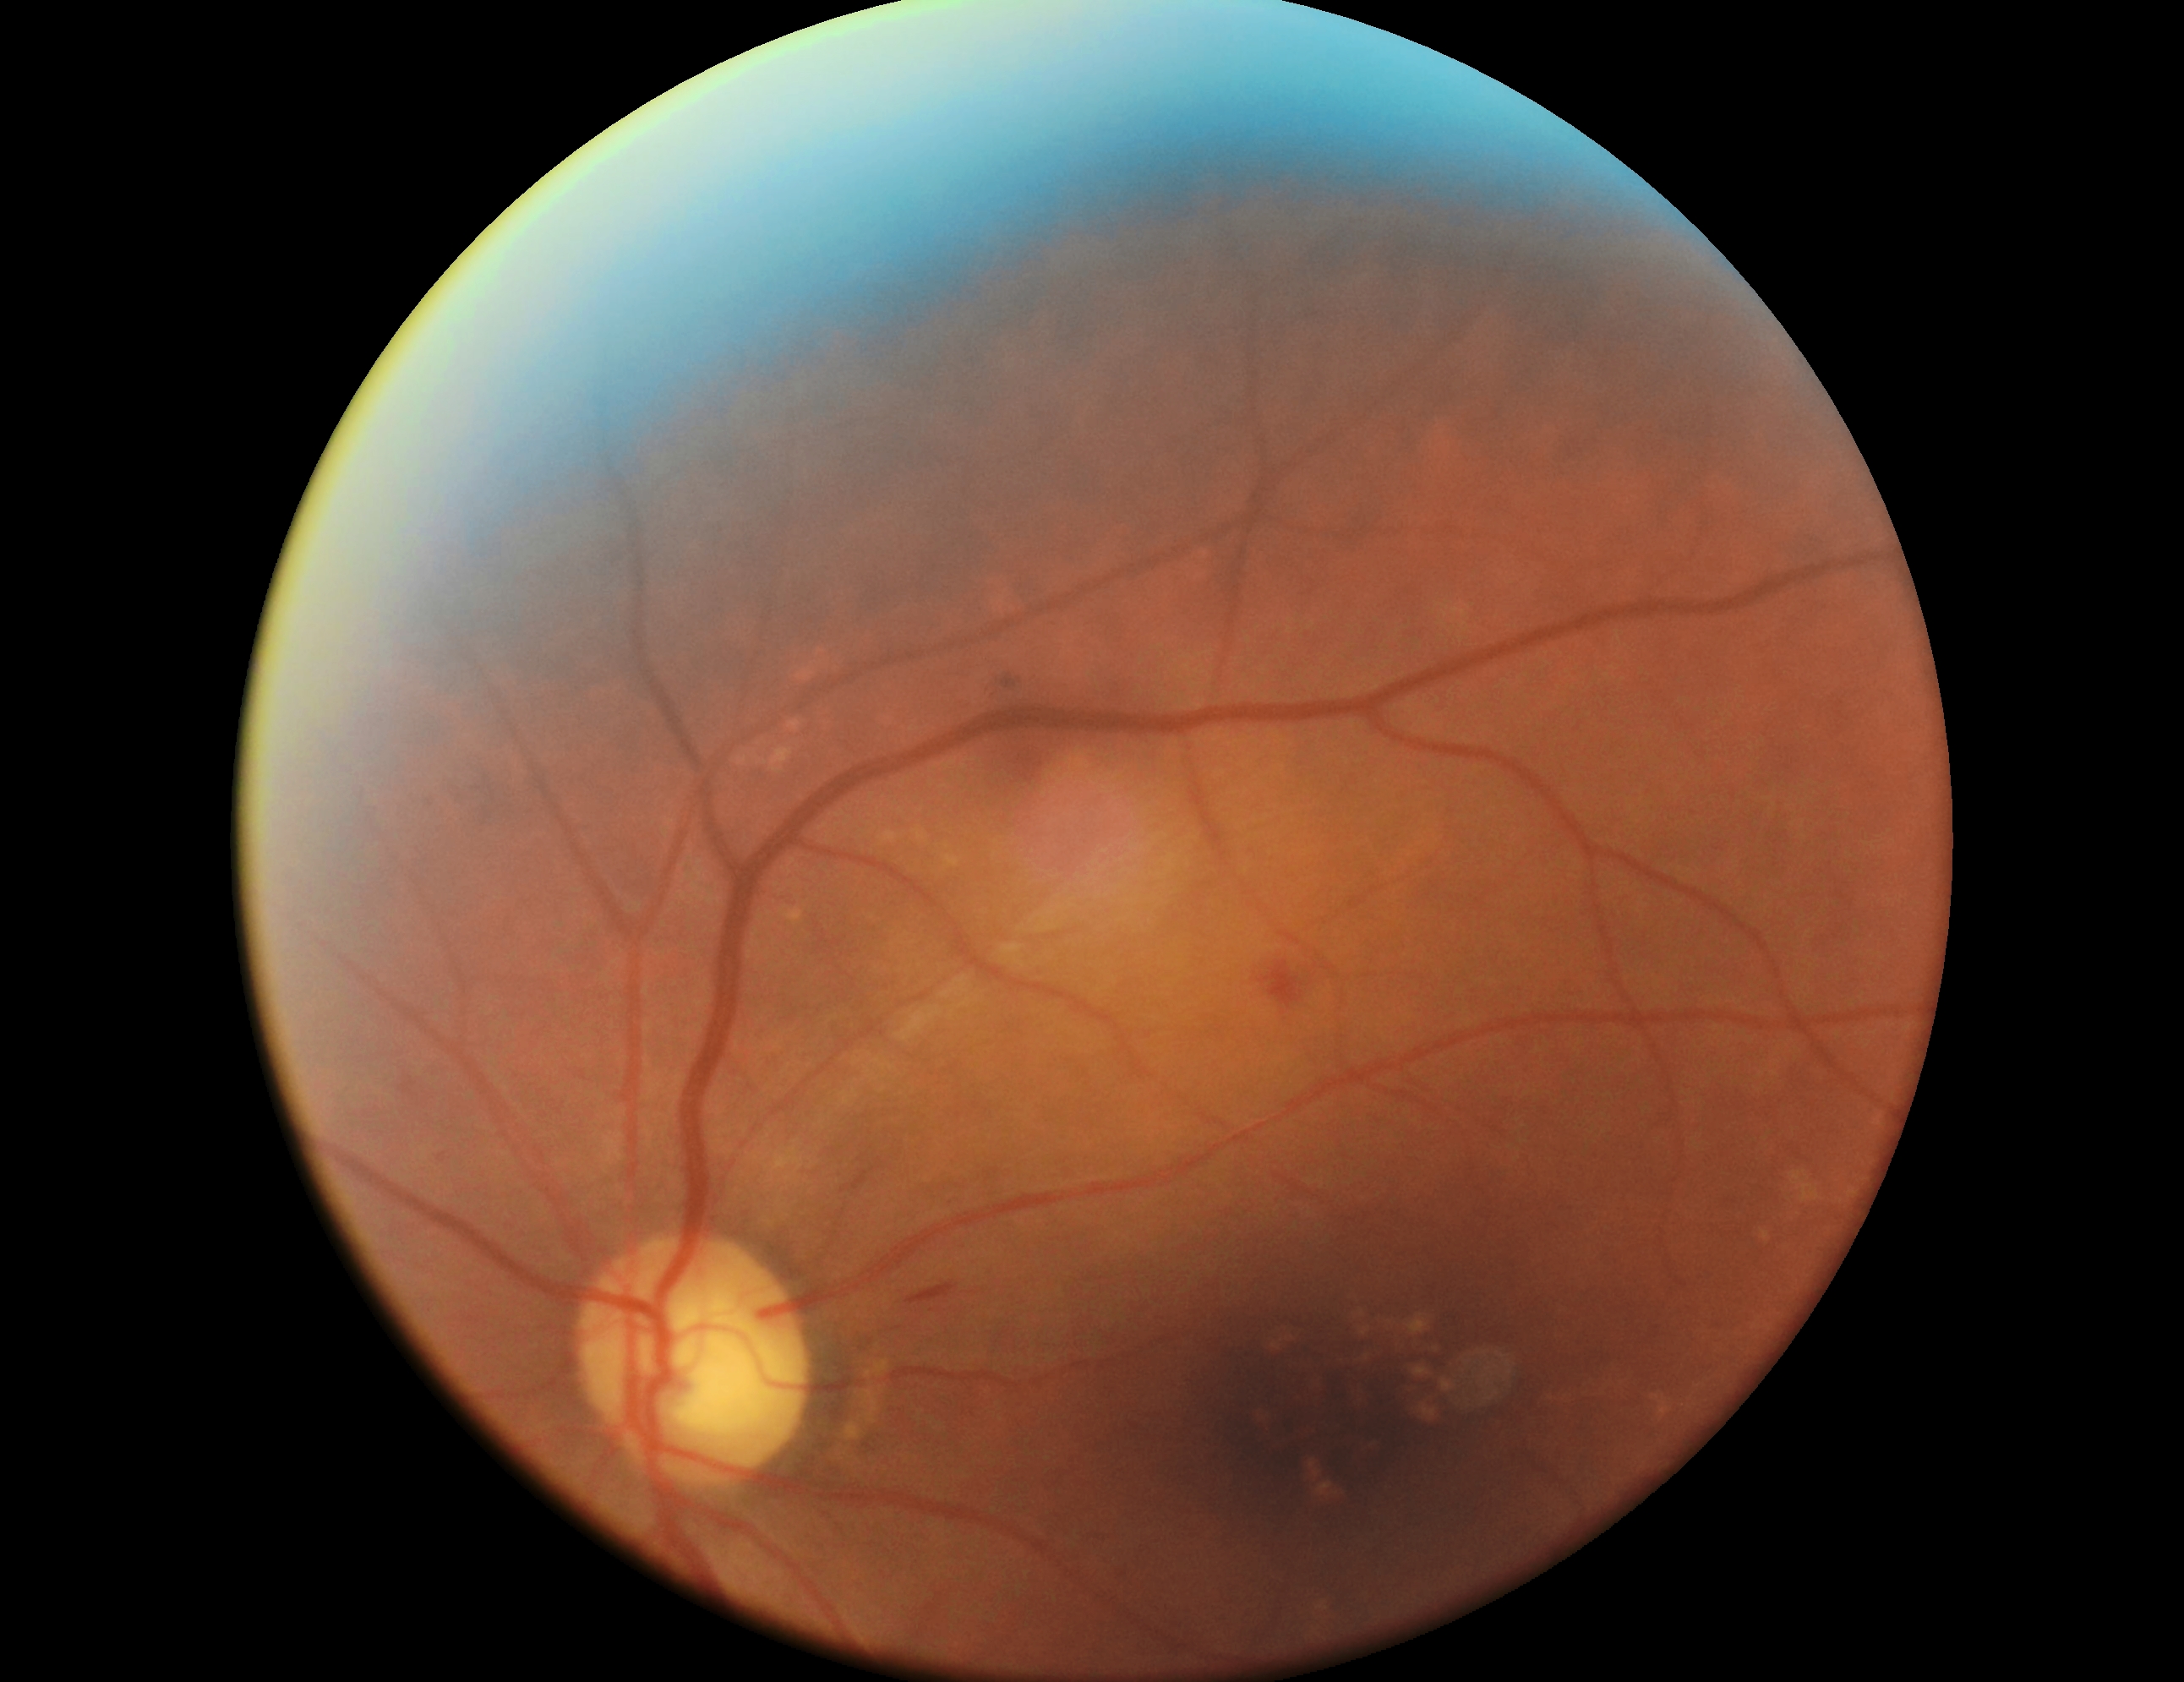 Retinopathy grade is 2.